Pediatric retinal photograph (wide-field) · 130° field of view (Clarity RetCam 3).
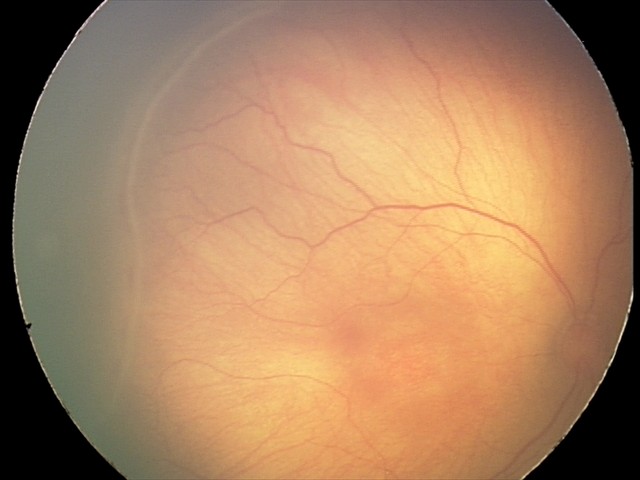
Without plus disease. Diagnosis from this screening exam: ROP stage 2.